Wide-field retinal mosaic image
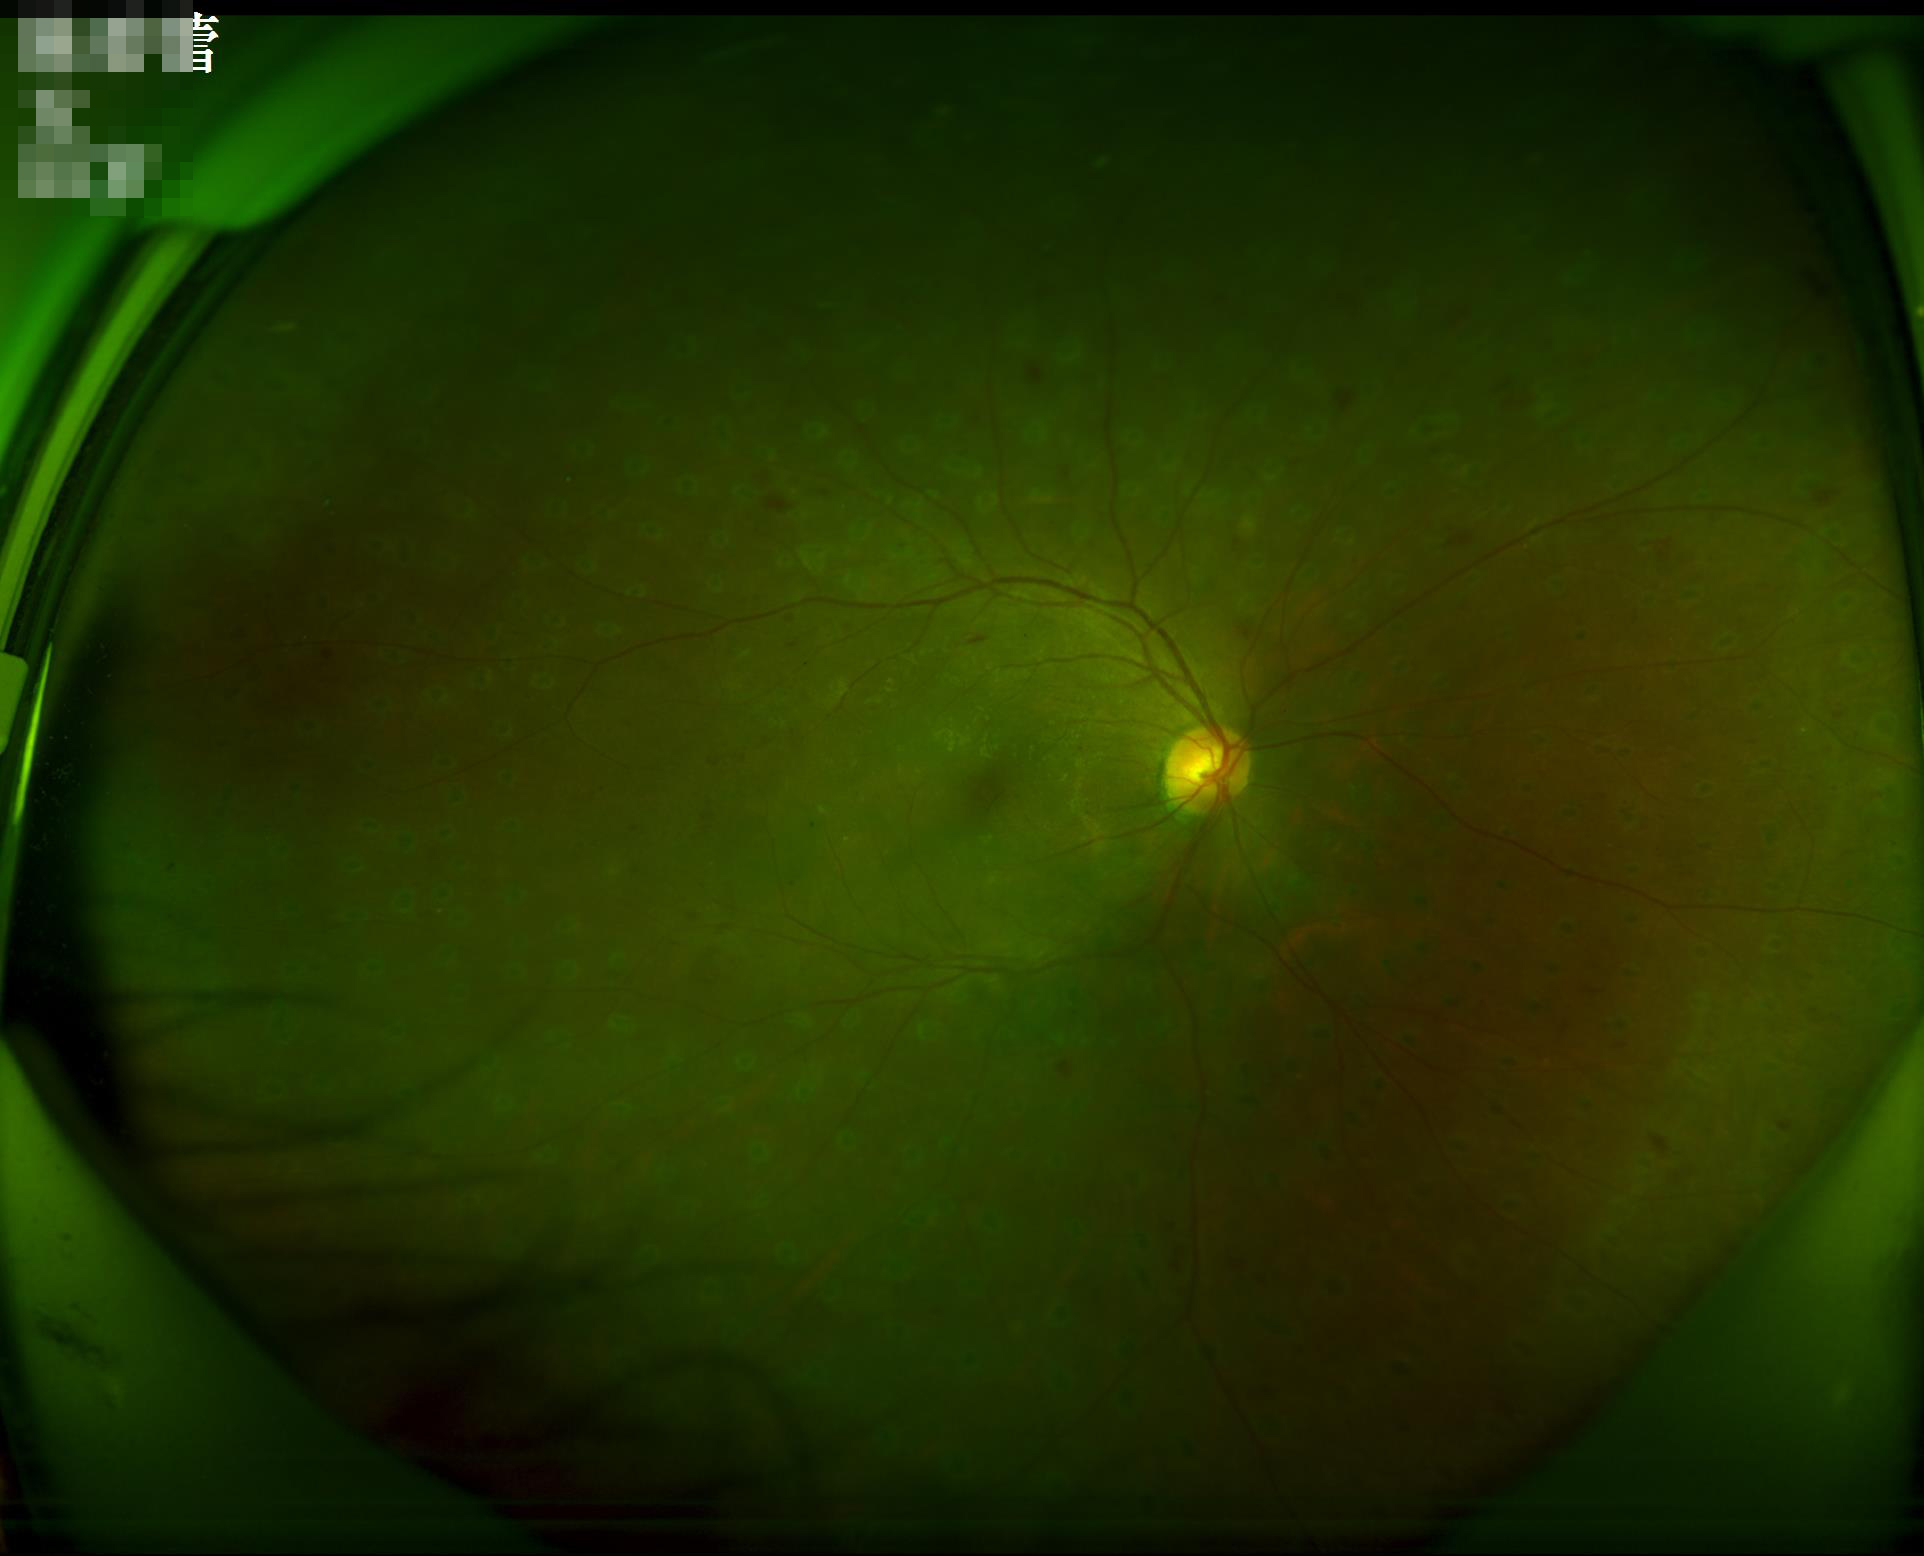 Overall quality is good and the image is gradable. The image is clear. Vessels and details are readily distinguishable.